Modified Davis classification:
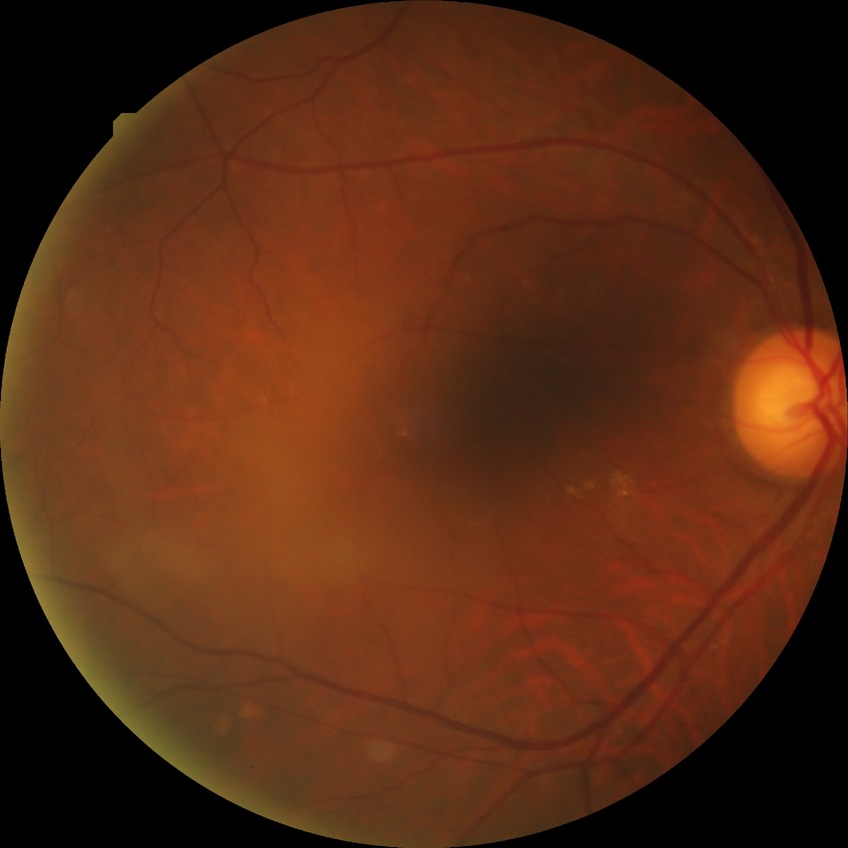

No signs of diabetic retinopathy.
DR grade: NDR.